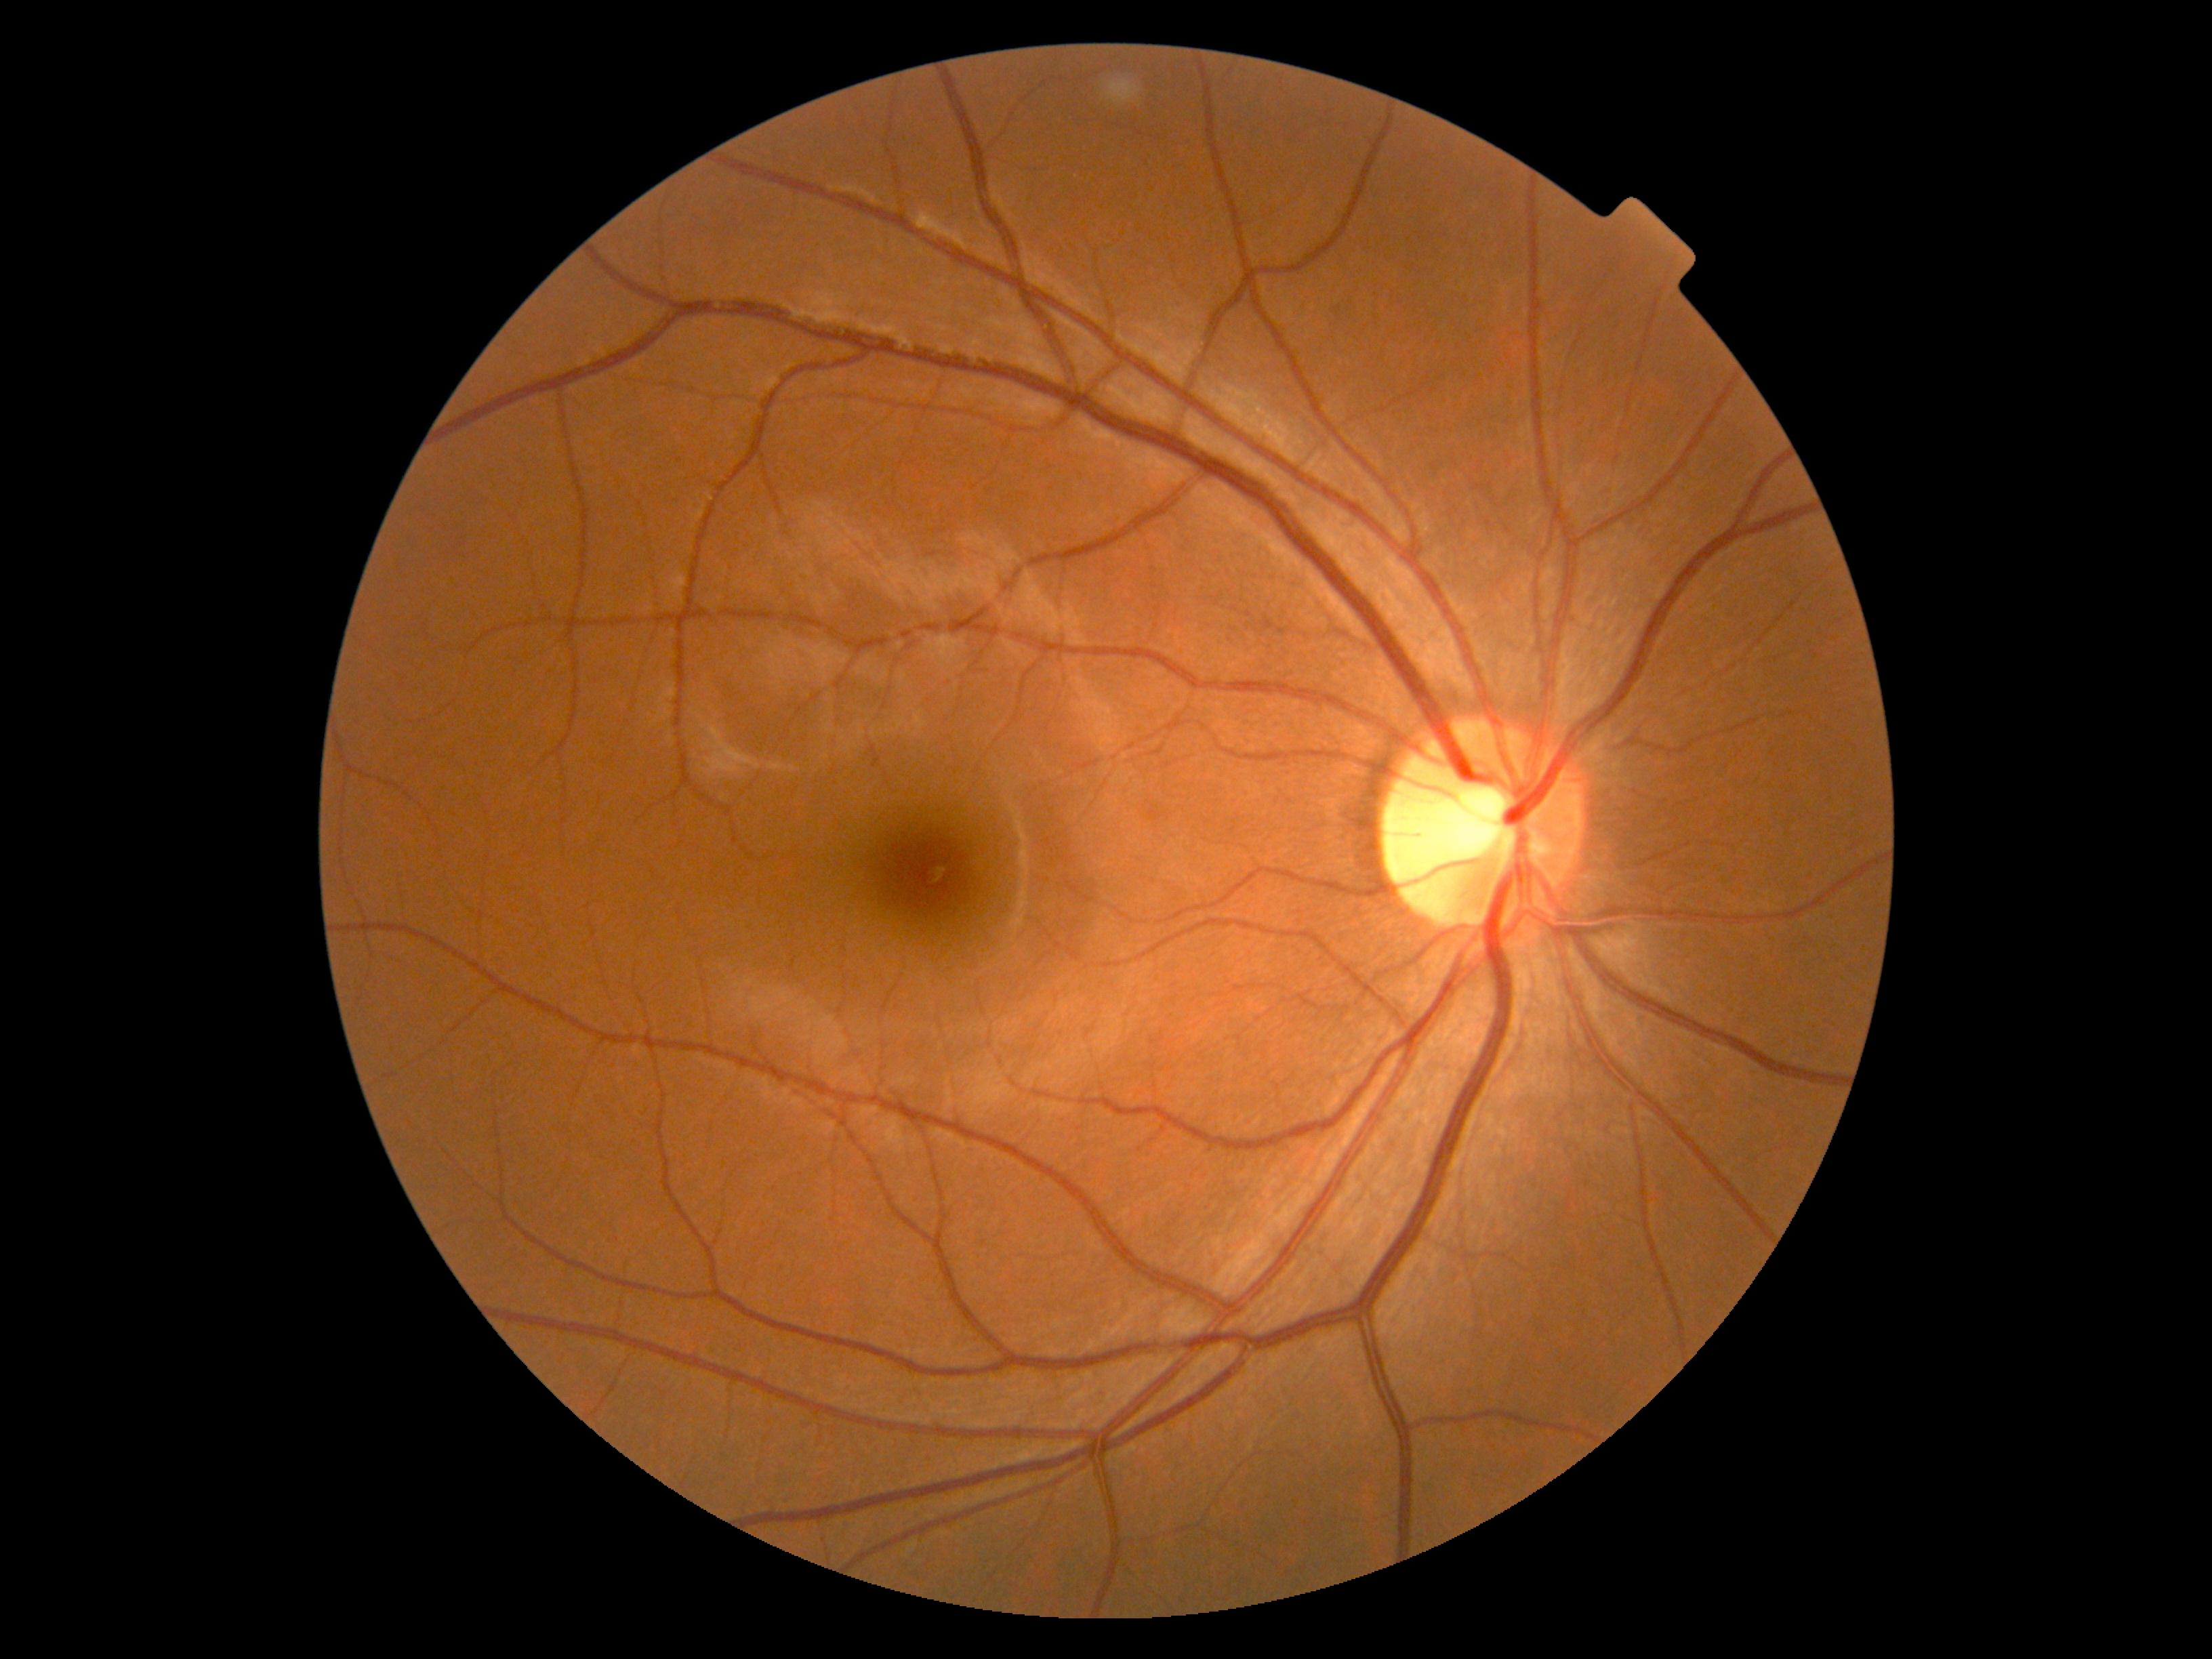 No signs of diabetic retinopathy. DR grade is 0 (no apparent retinopathy).